45° field of view; NIDEK AFC-230 fundus camera; color fundus photograph: 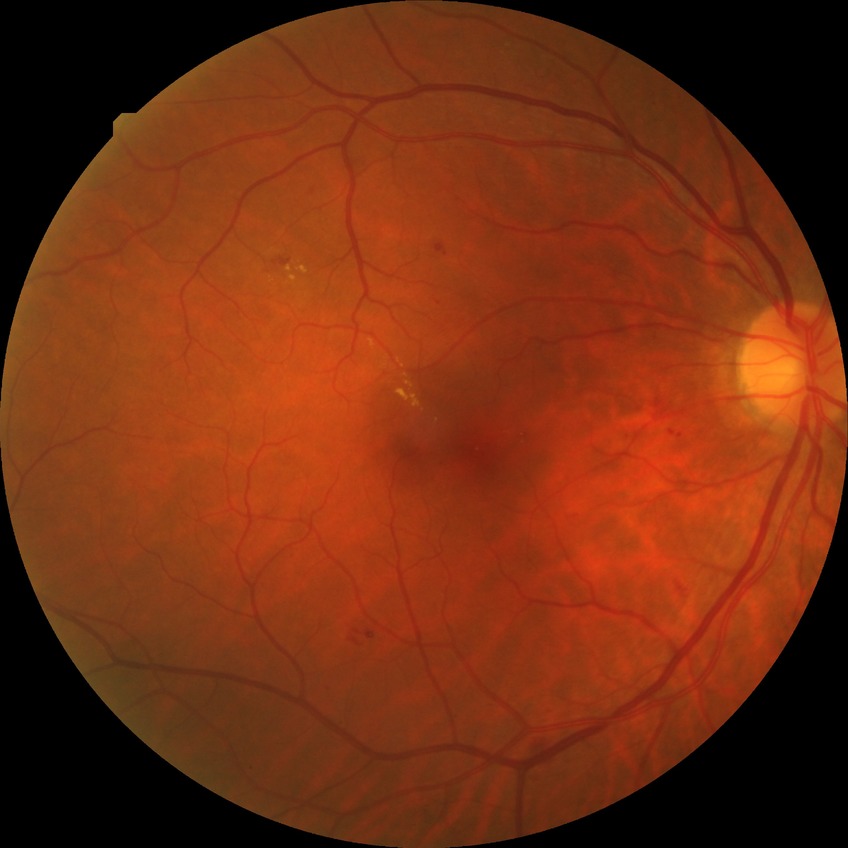

diabetic retinopathy (DR) = SDR (simple diabetic retinopathy), DR class = non-proliferative diabetic retinopathy.